848 by 848 pixels: 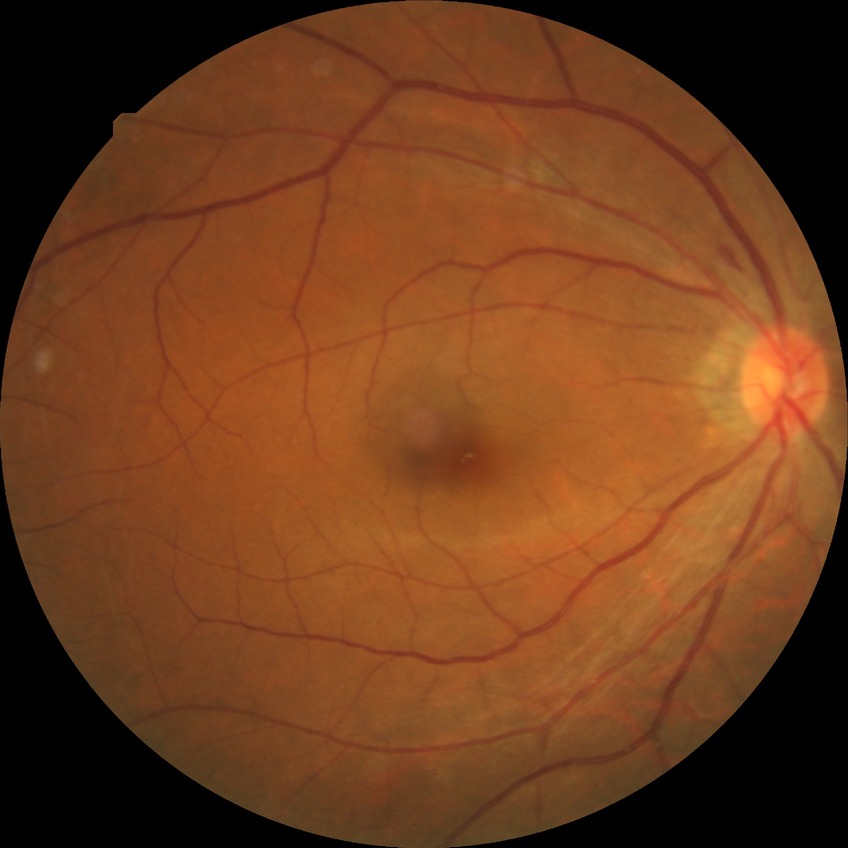 Diabetic retinopathy (DR) is no diabetic retinopathy (NDR).